45° FOV, 2352x1568.
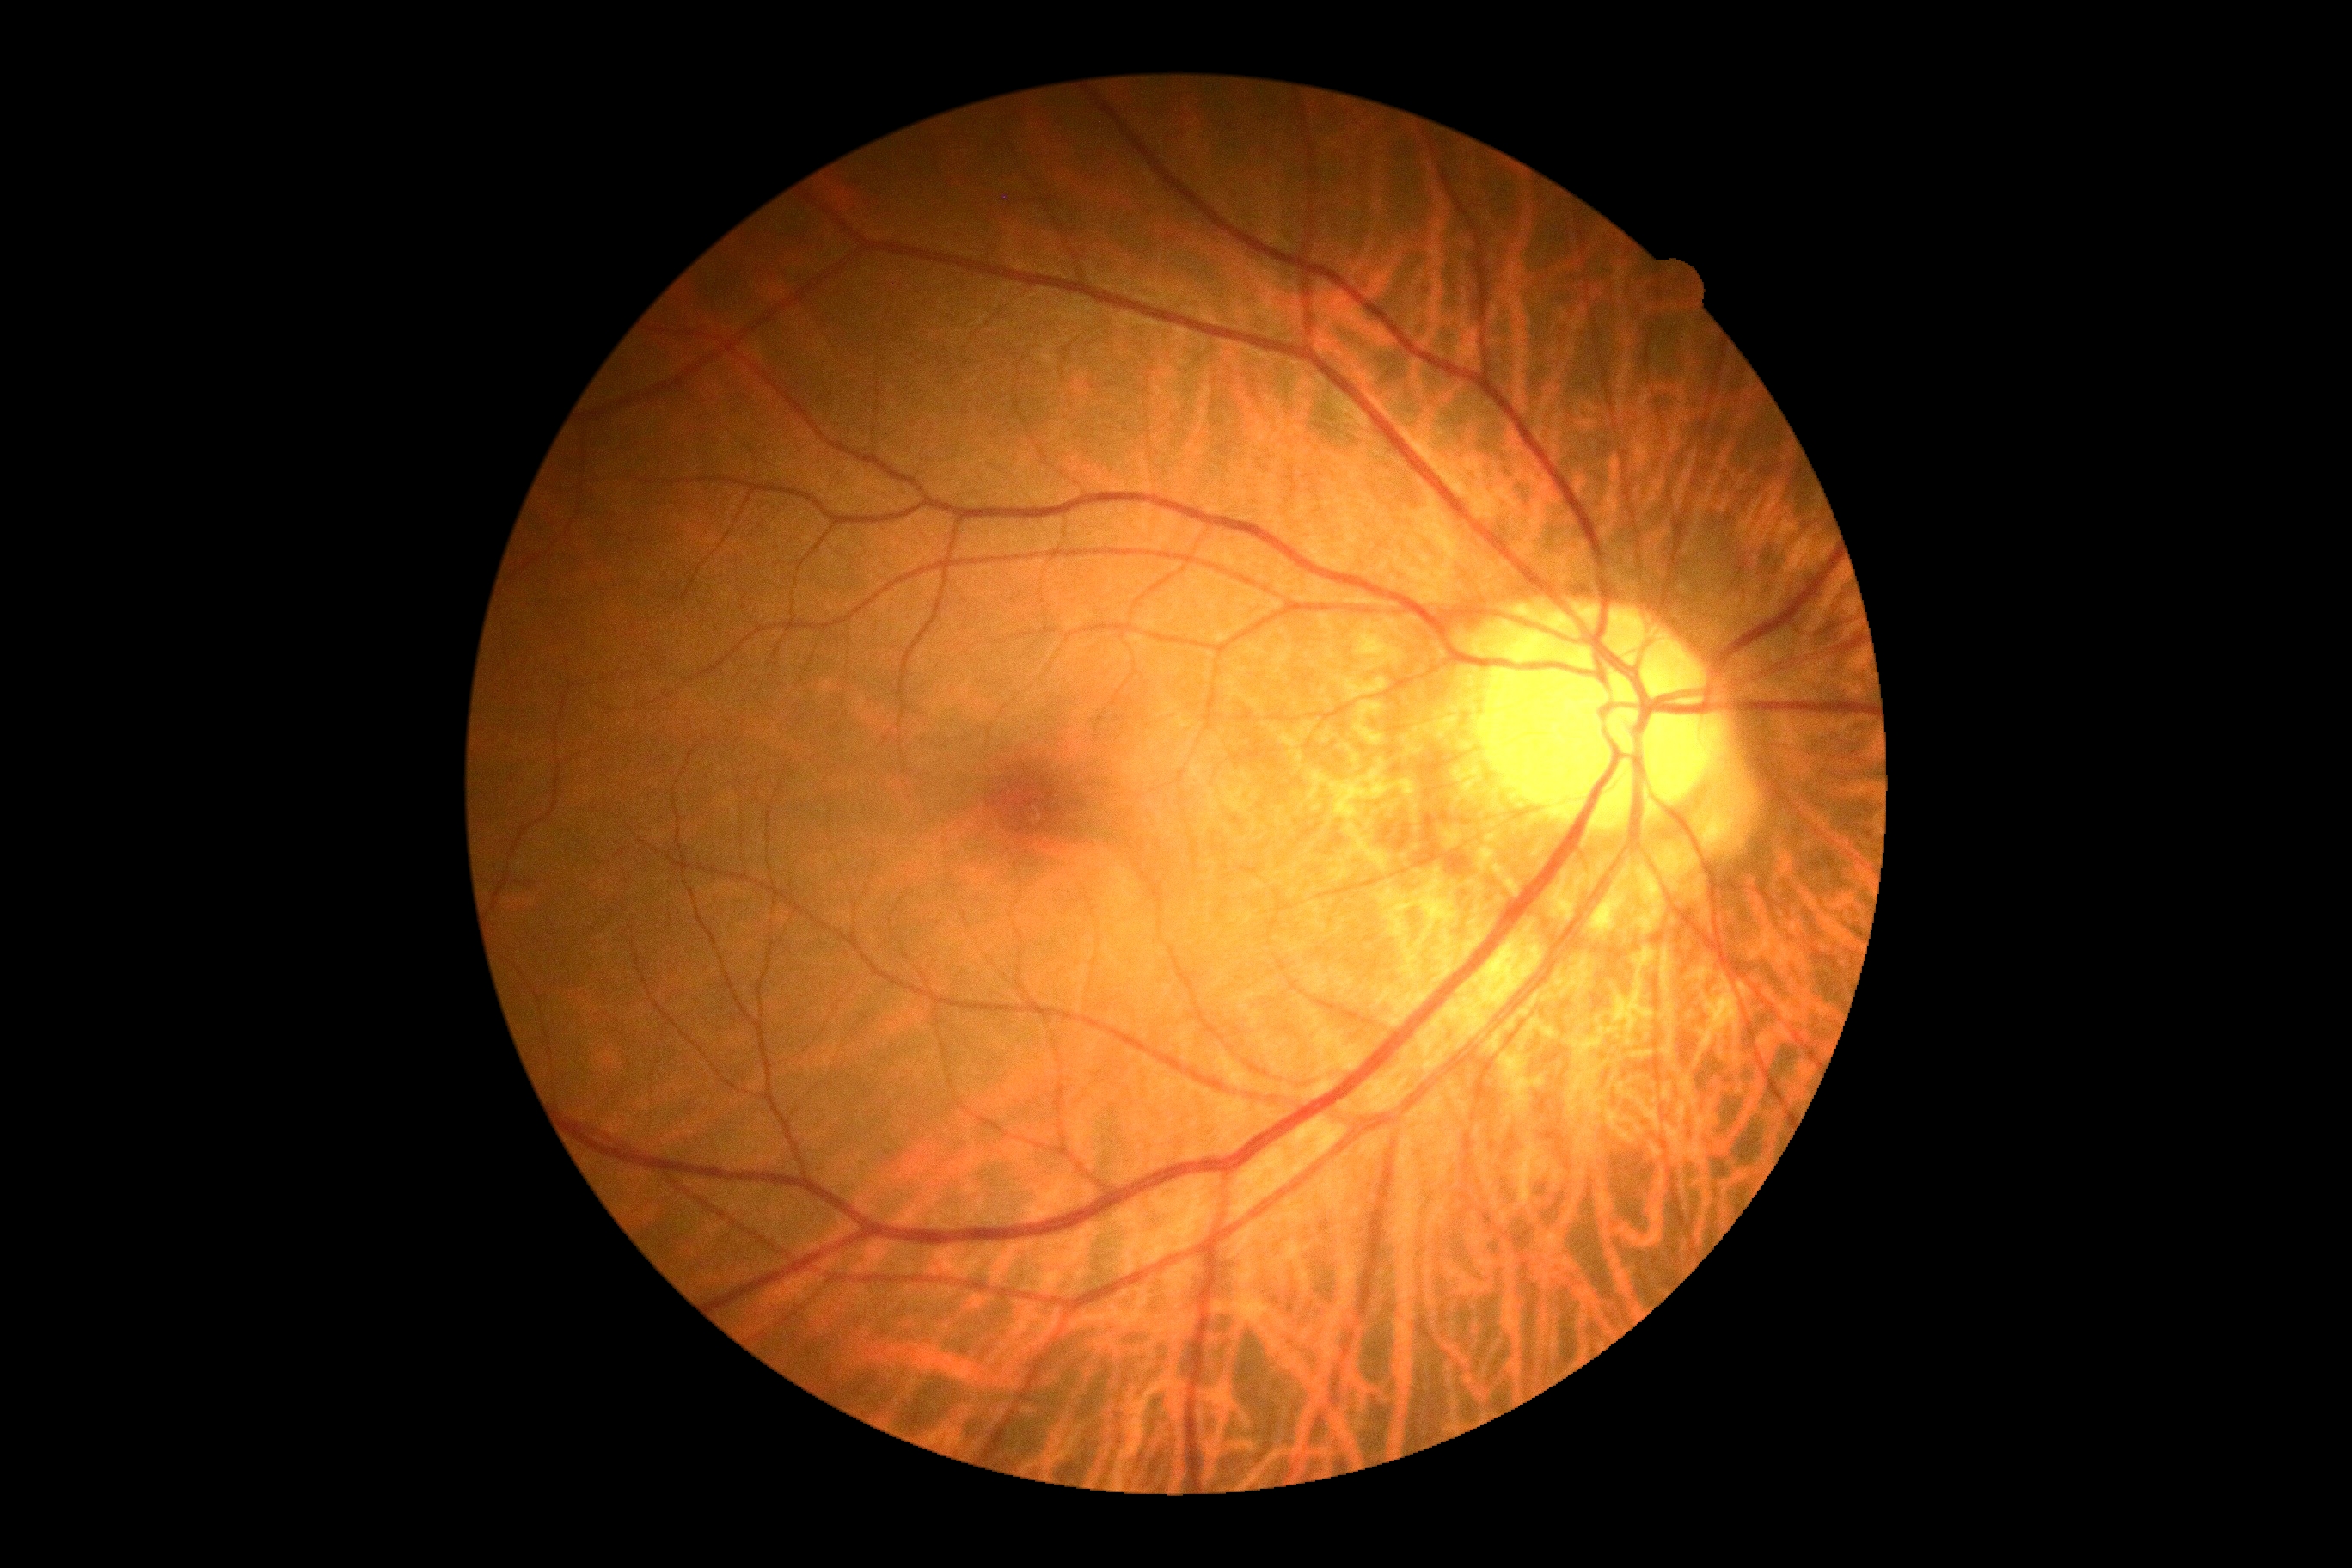

No DR findings. Diabetic retinopathy (DR): no apparent diabetic retinopathy (grade 0) — no visible signs of diabetic retinopathy.